No pharmacologic dilation; image size 848x848; camera: NIDEK AFC-230; modified Davis classification:
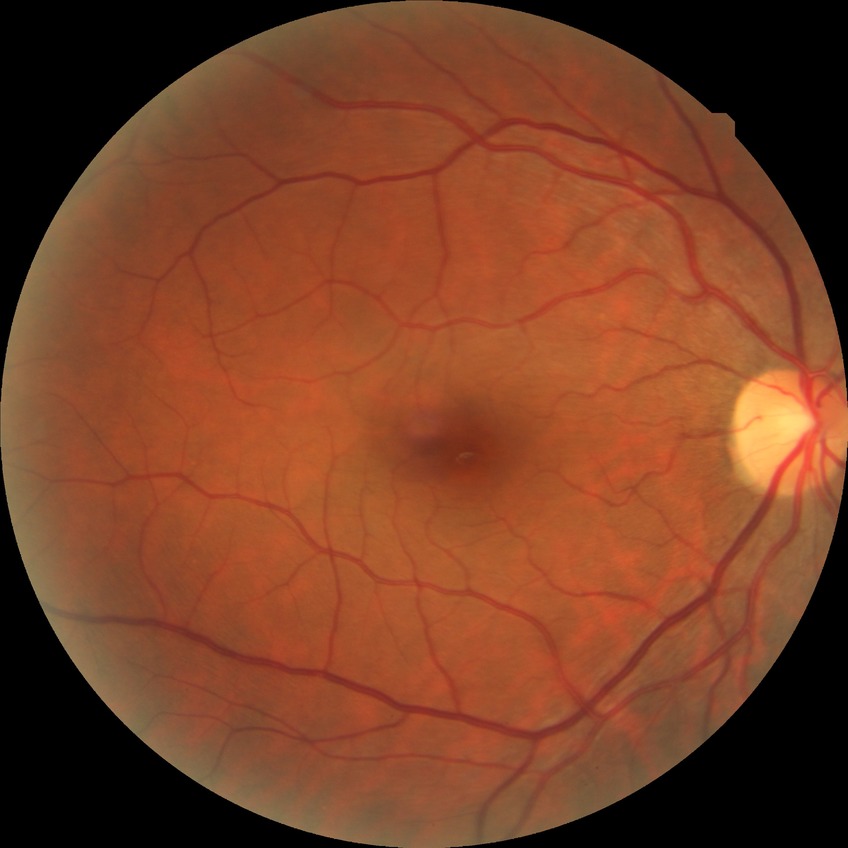
Diabetic retinopathy (DR): NDR (no diabetic retinopathy).